45° FOV · image size 848x848 · CFP: 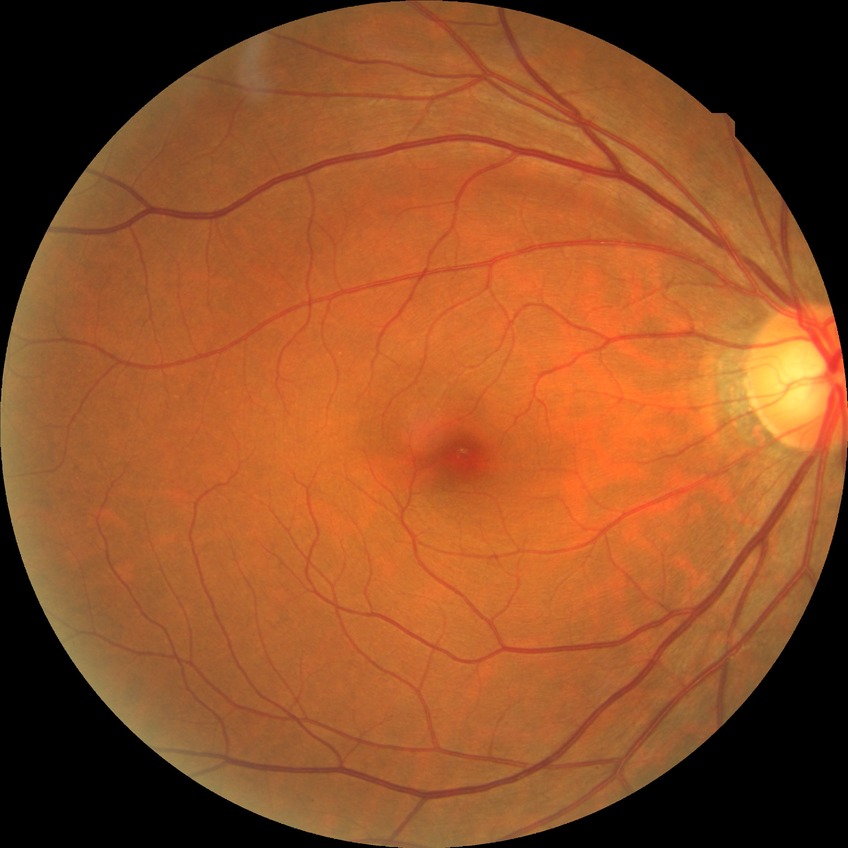

Assessment:
– diabetic retinopathy grade — no diabetic retinopathy